Color fundus photograph:
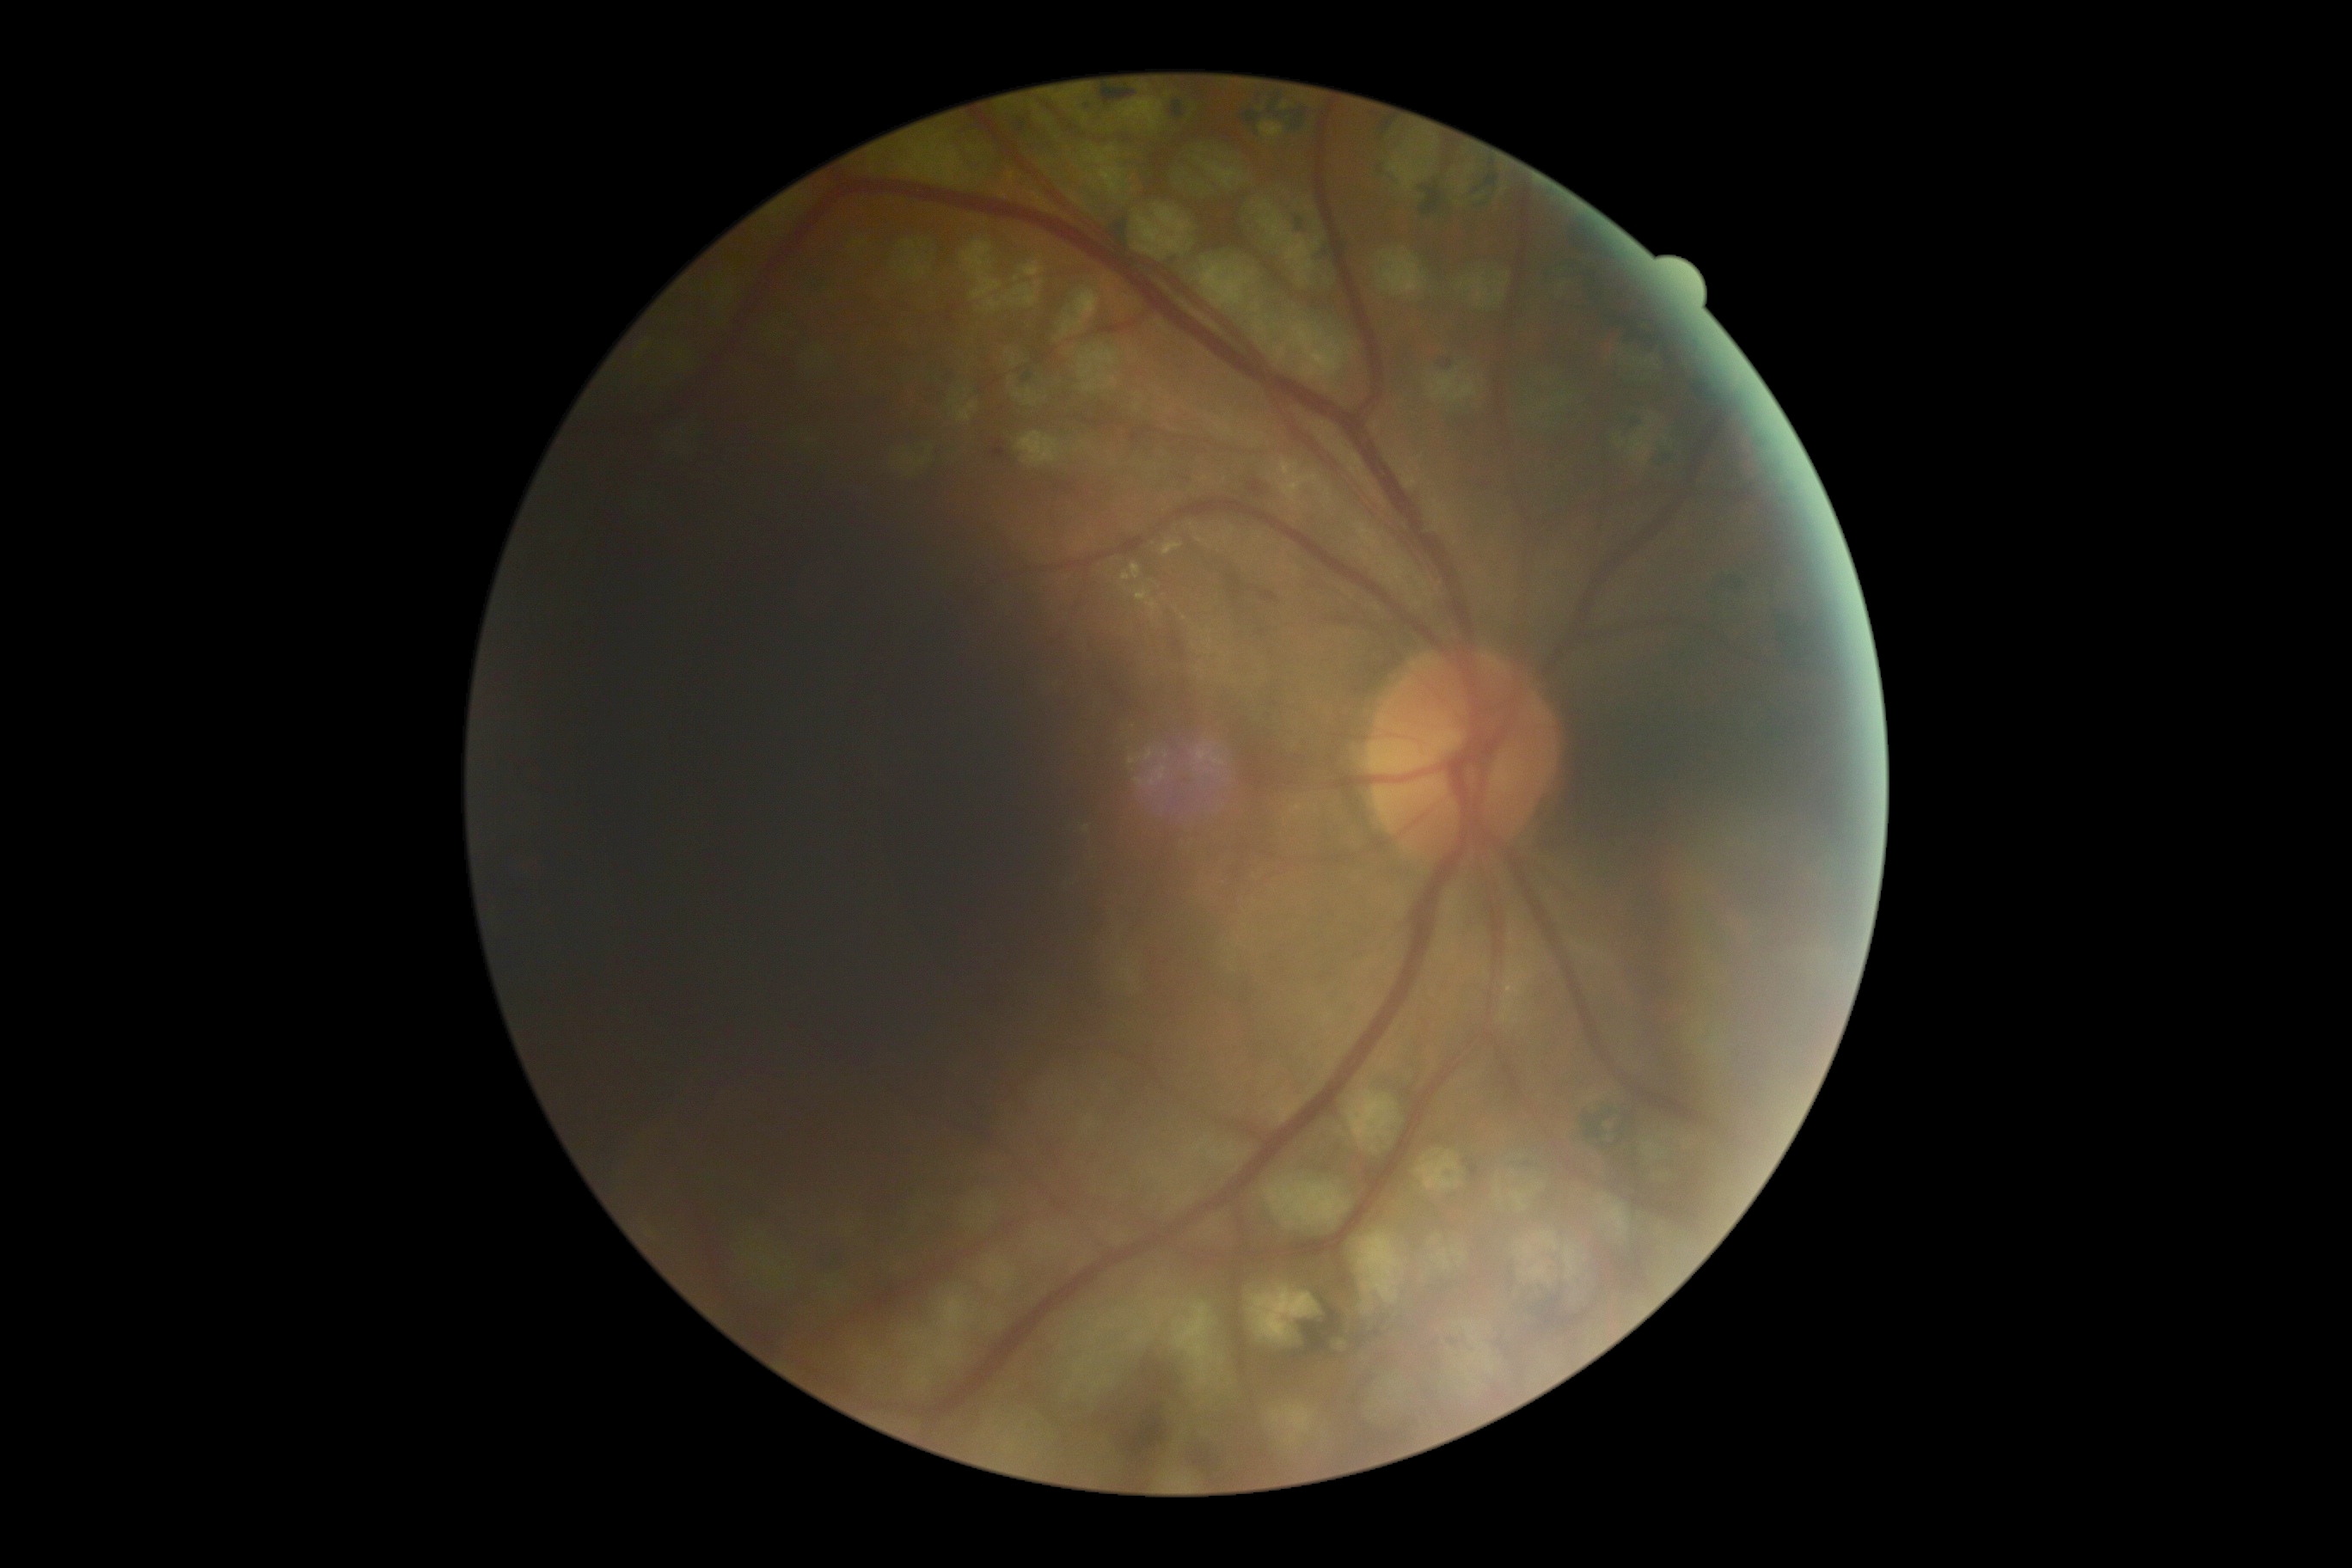
diabetic retinopathy severity@2.